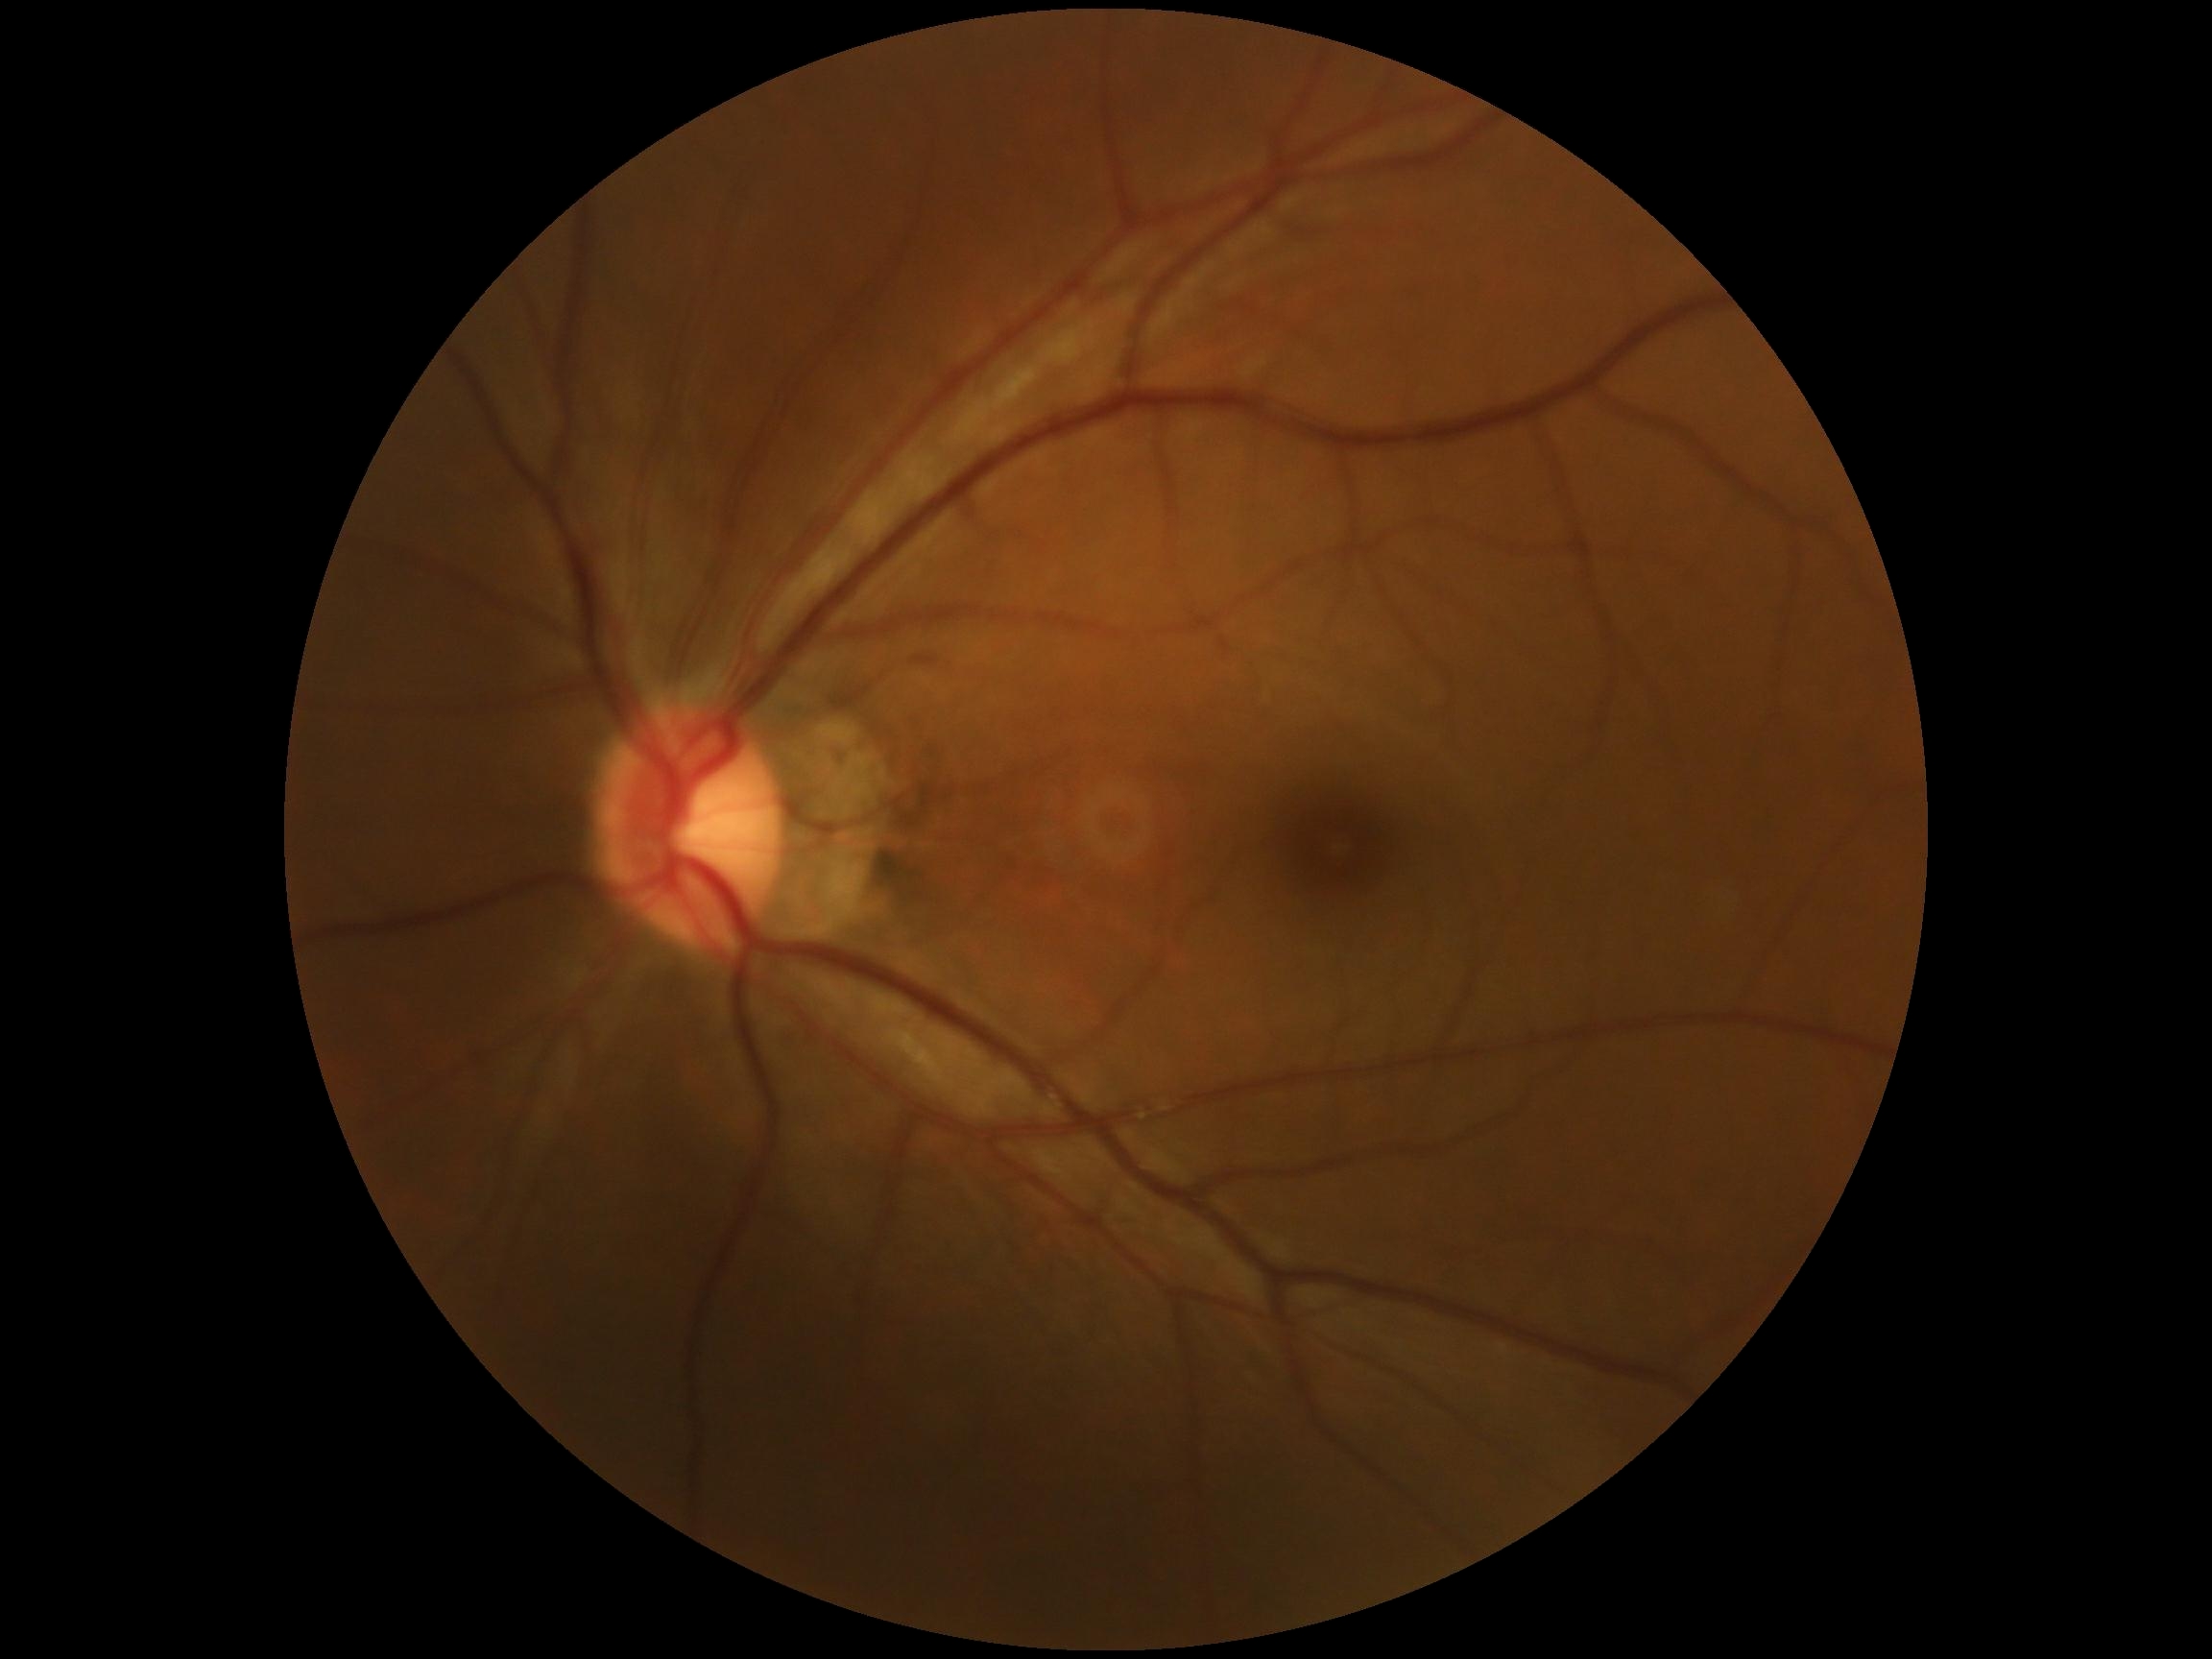
{"dr_impression": "no apparent DR", "dr_grade": "0"}